Pediatric retinal photograph (wide-field) — 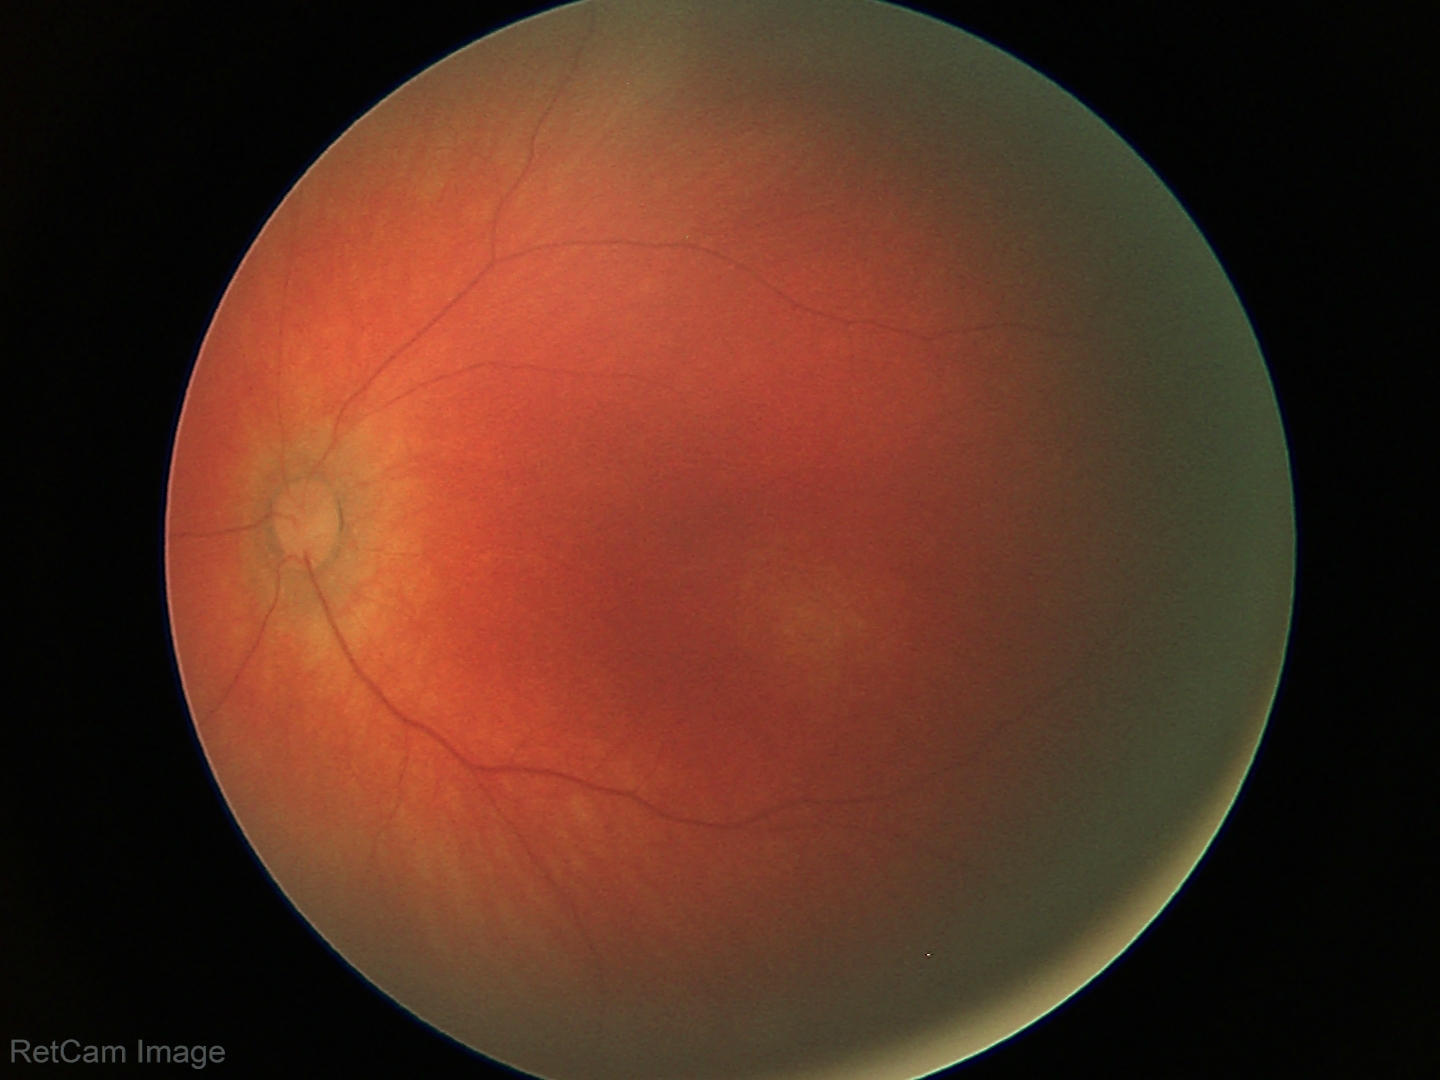

Screening examination diagnosed as physiological.